Color fundus photograph — 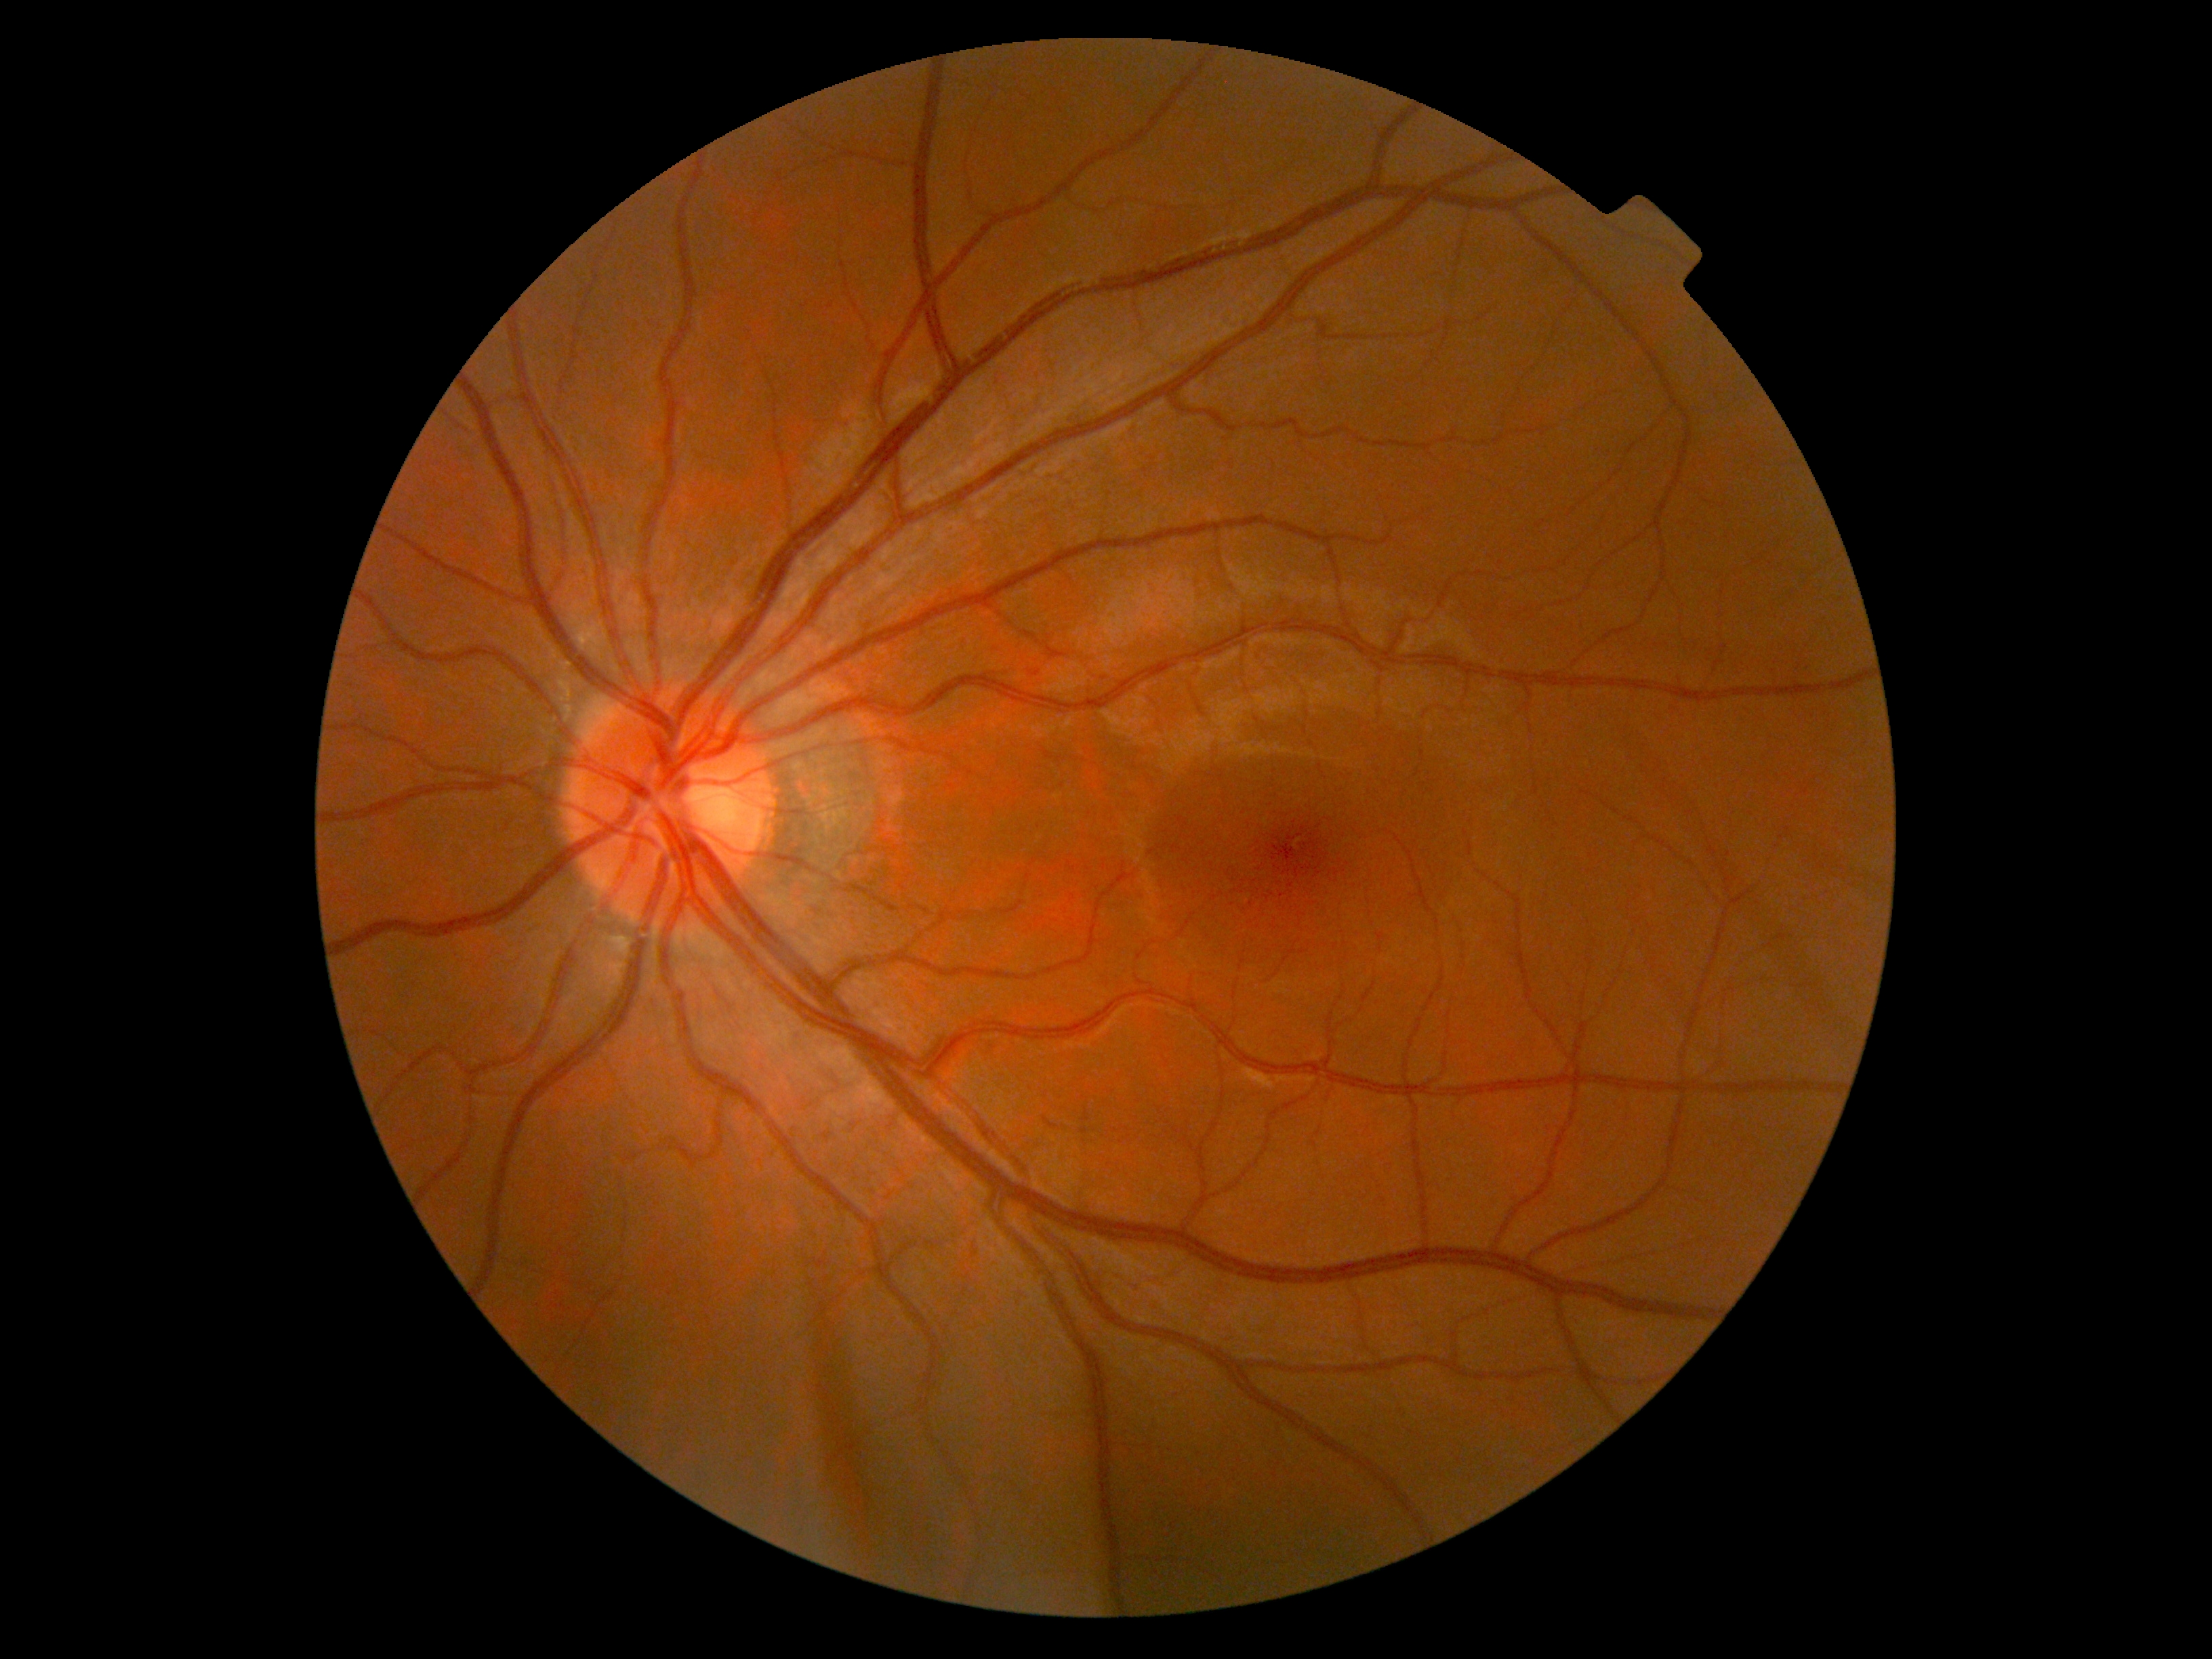
No apparent diabetic retinopathy.
DR: grade 0 (no apparent retinopathy).